45° field of view; image size 2352x1568
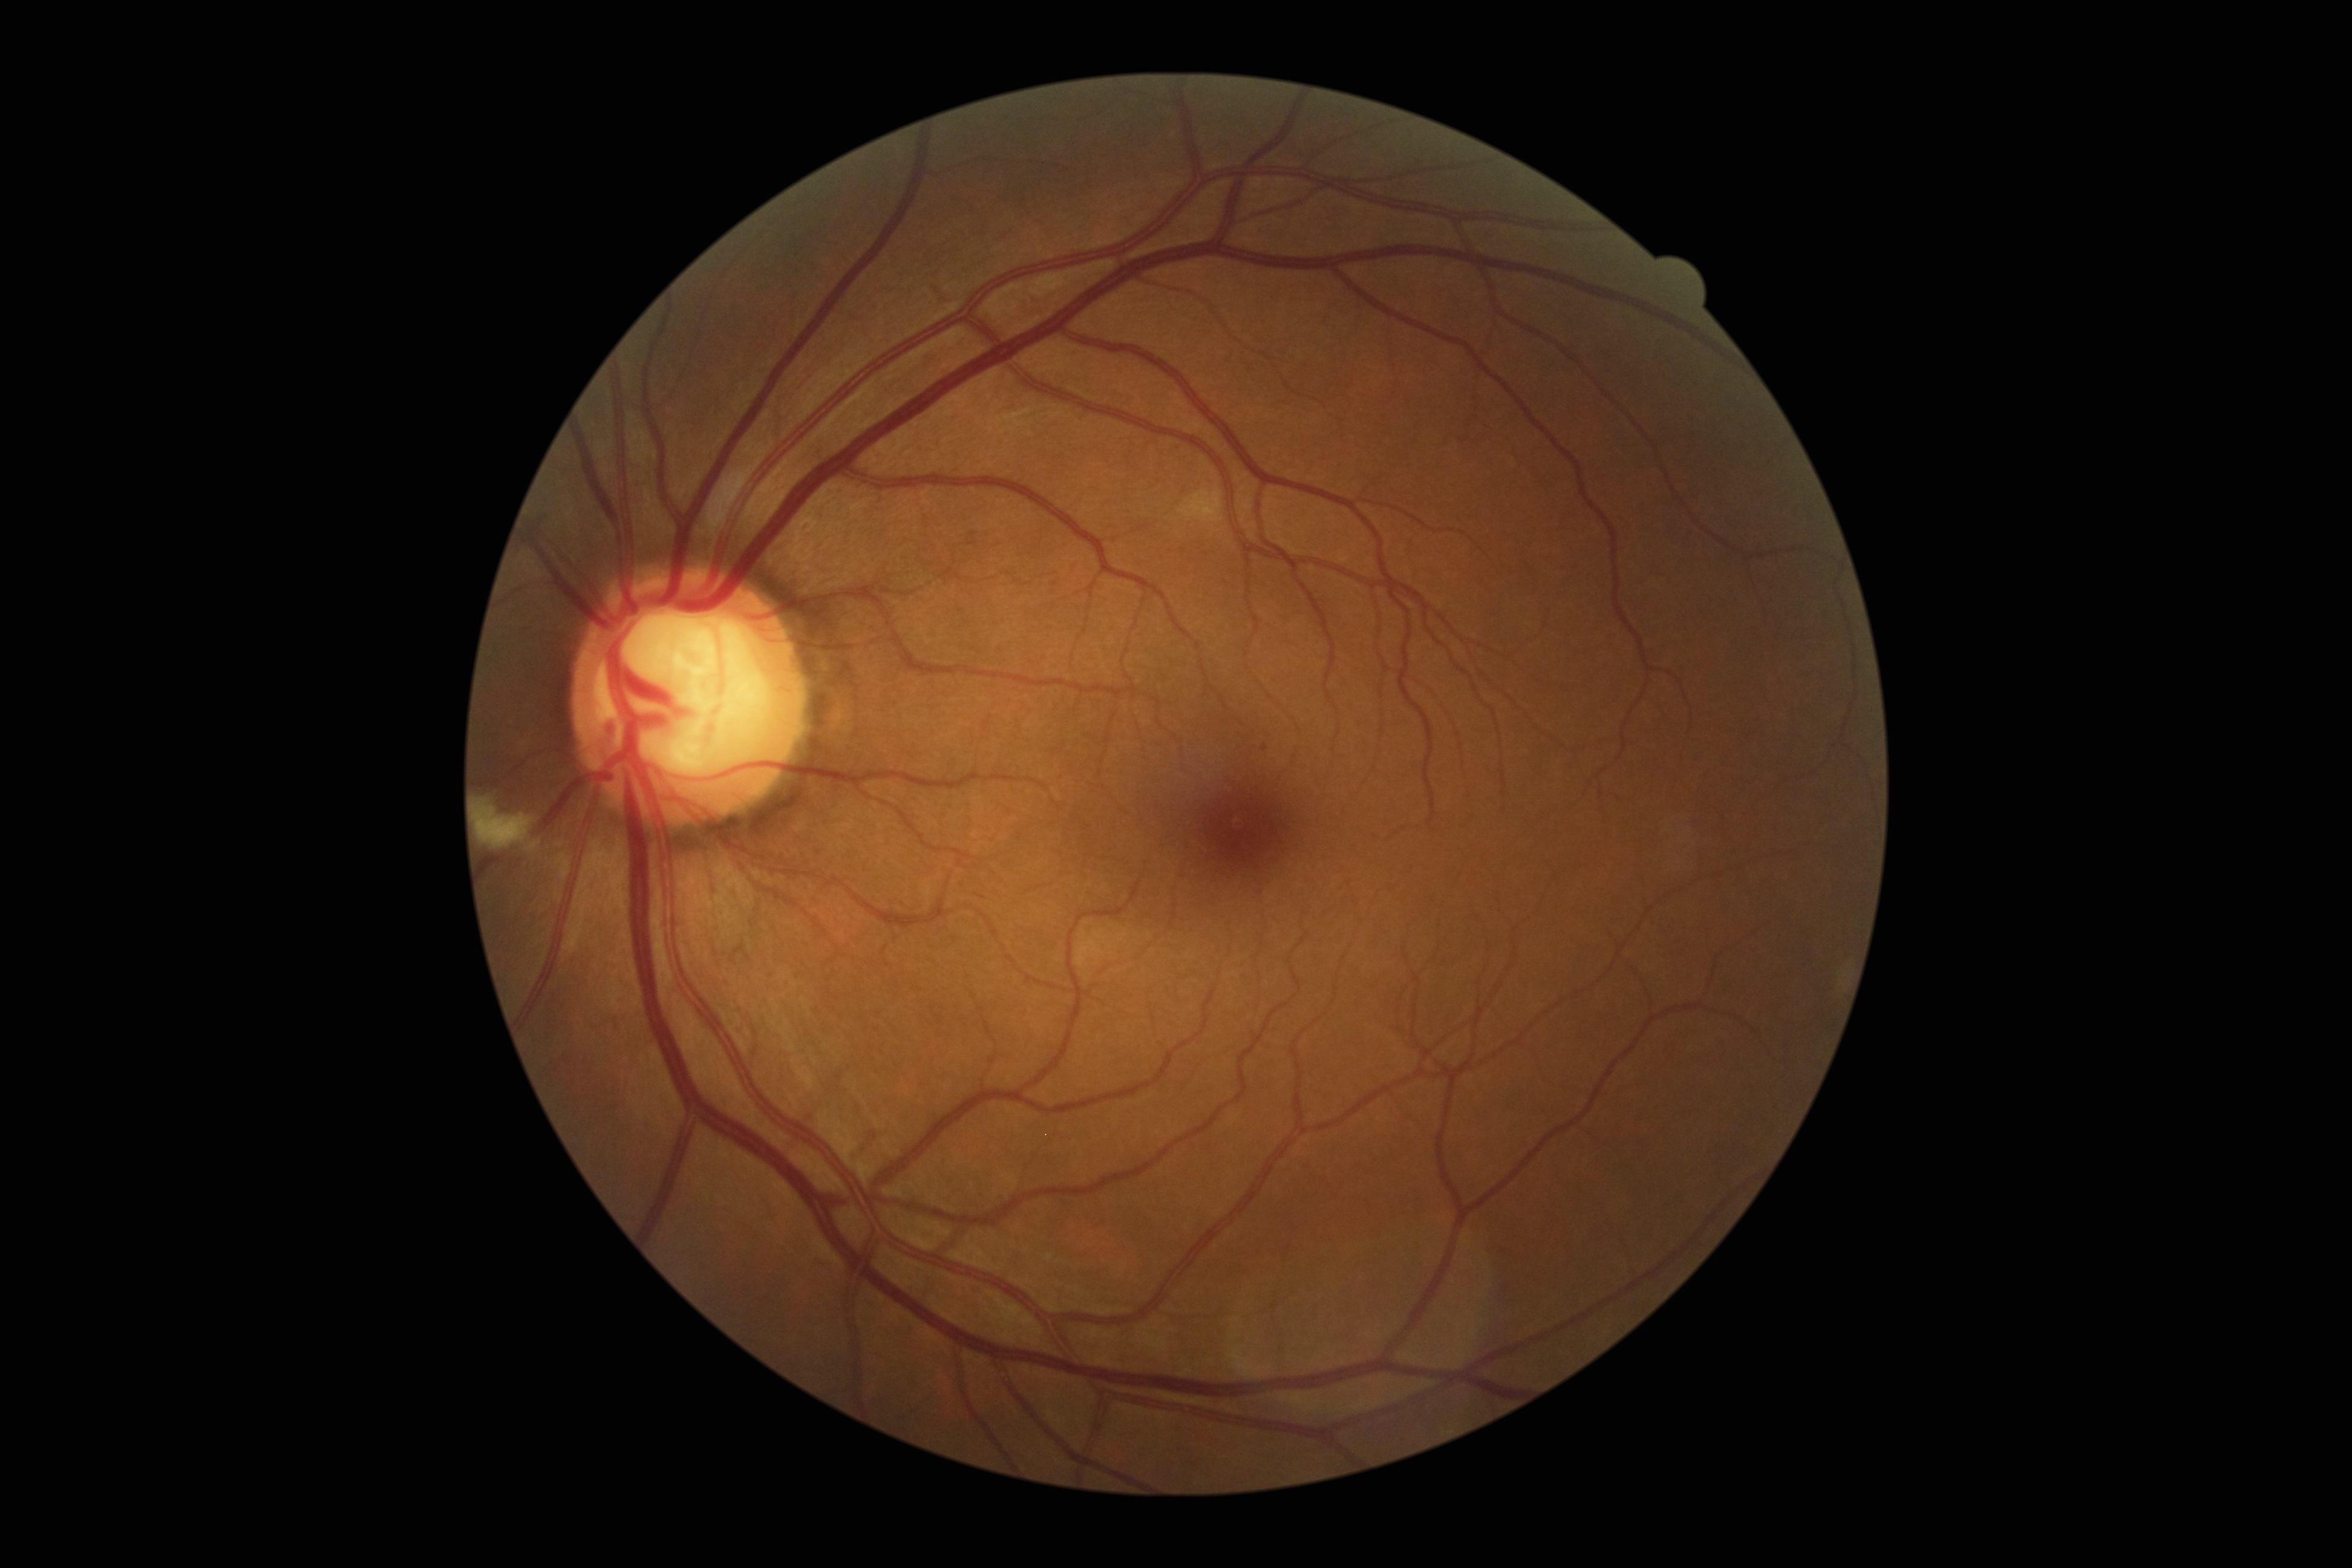   dr_grade: moderate non-proliferative diabetic retinopathy (grade 2)
  dr_category: non-proliferative diabetic retinopathy